45° FOV, 2352x1568px.
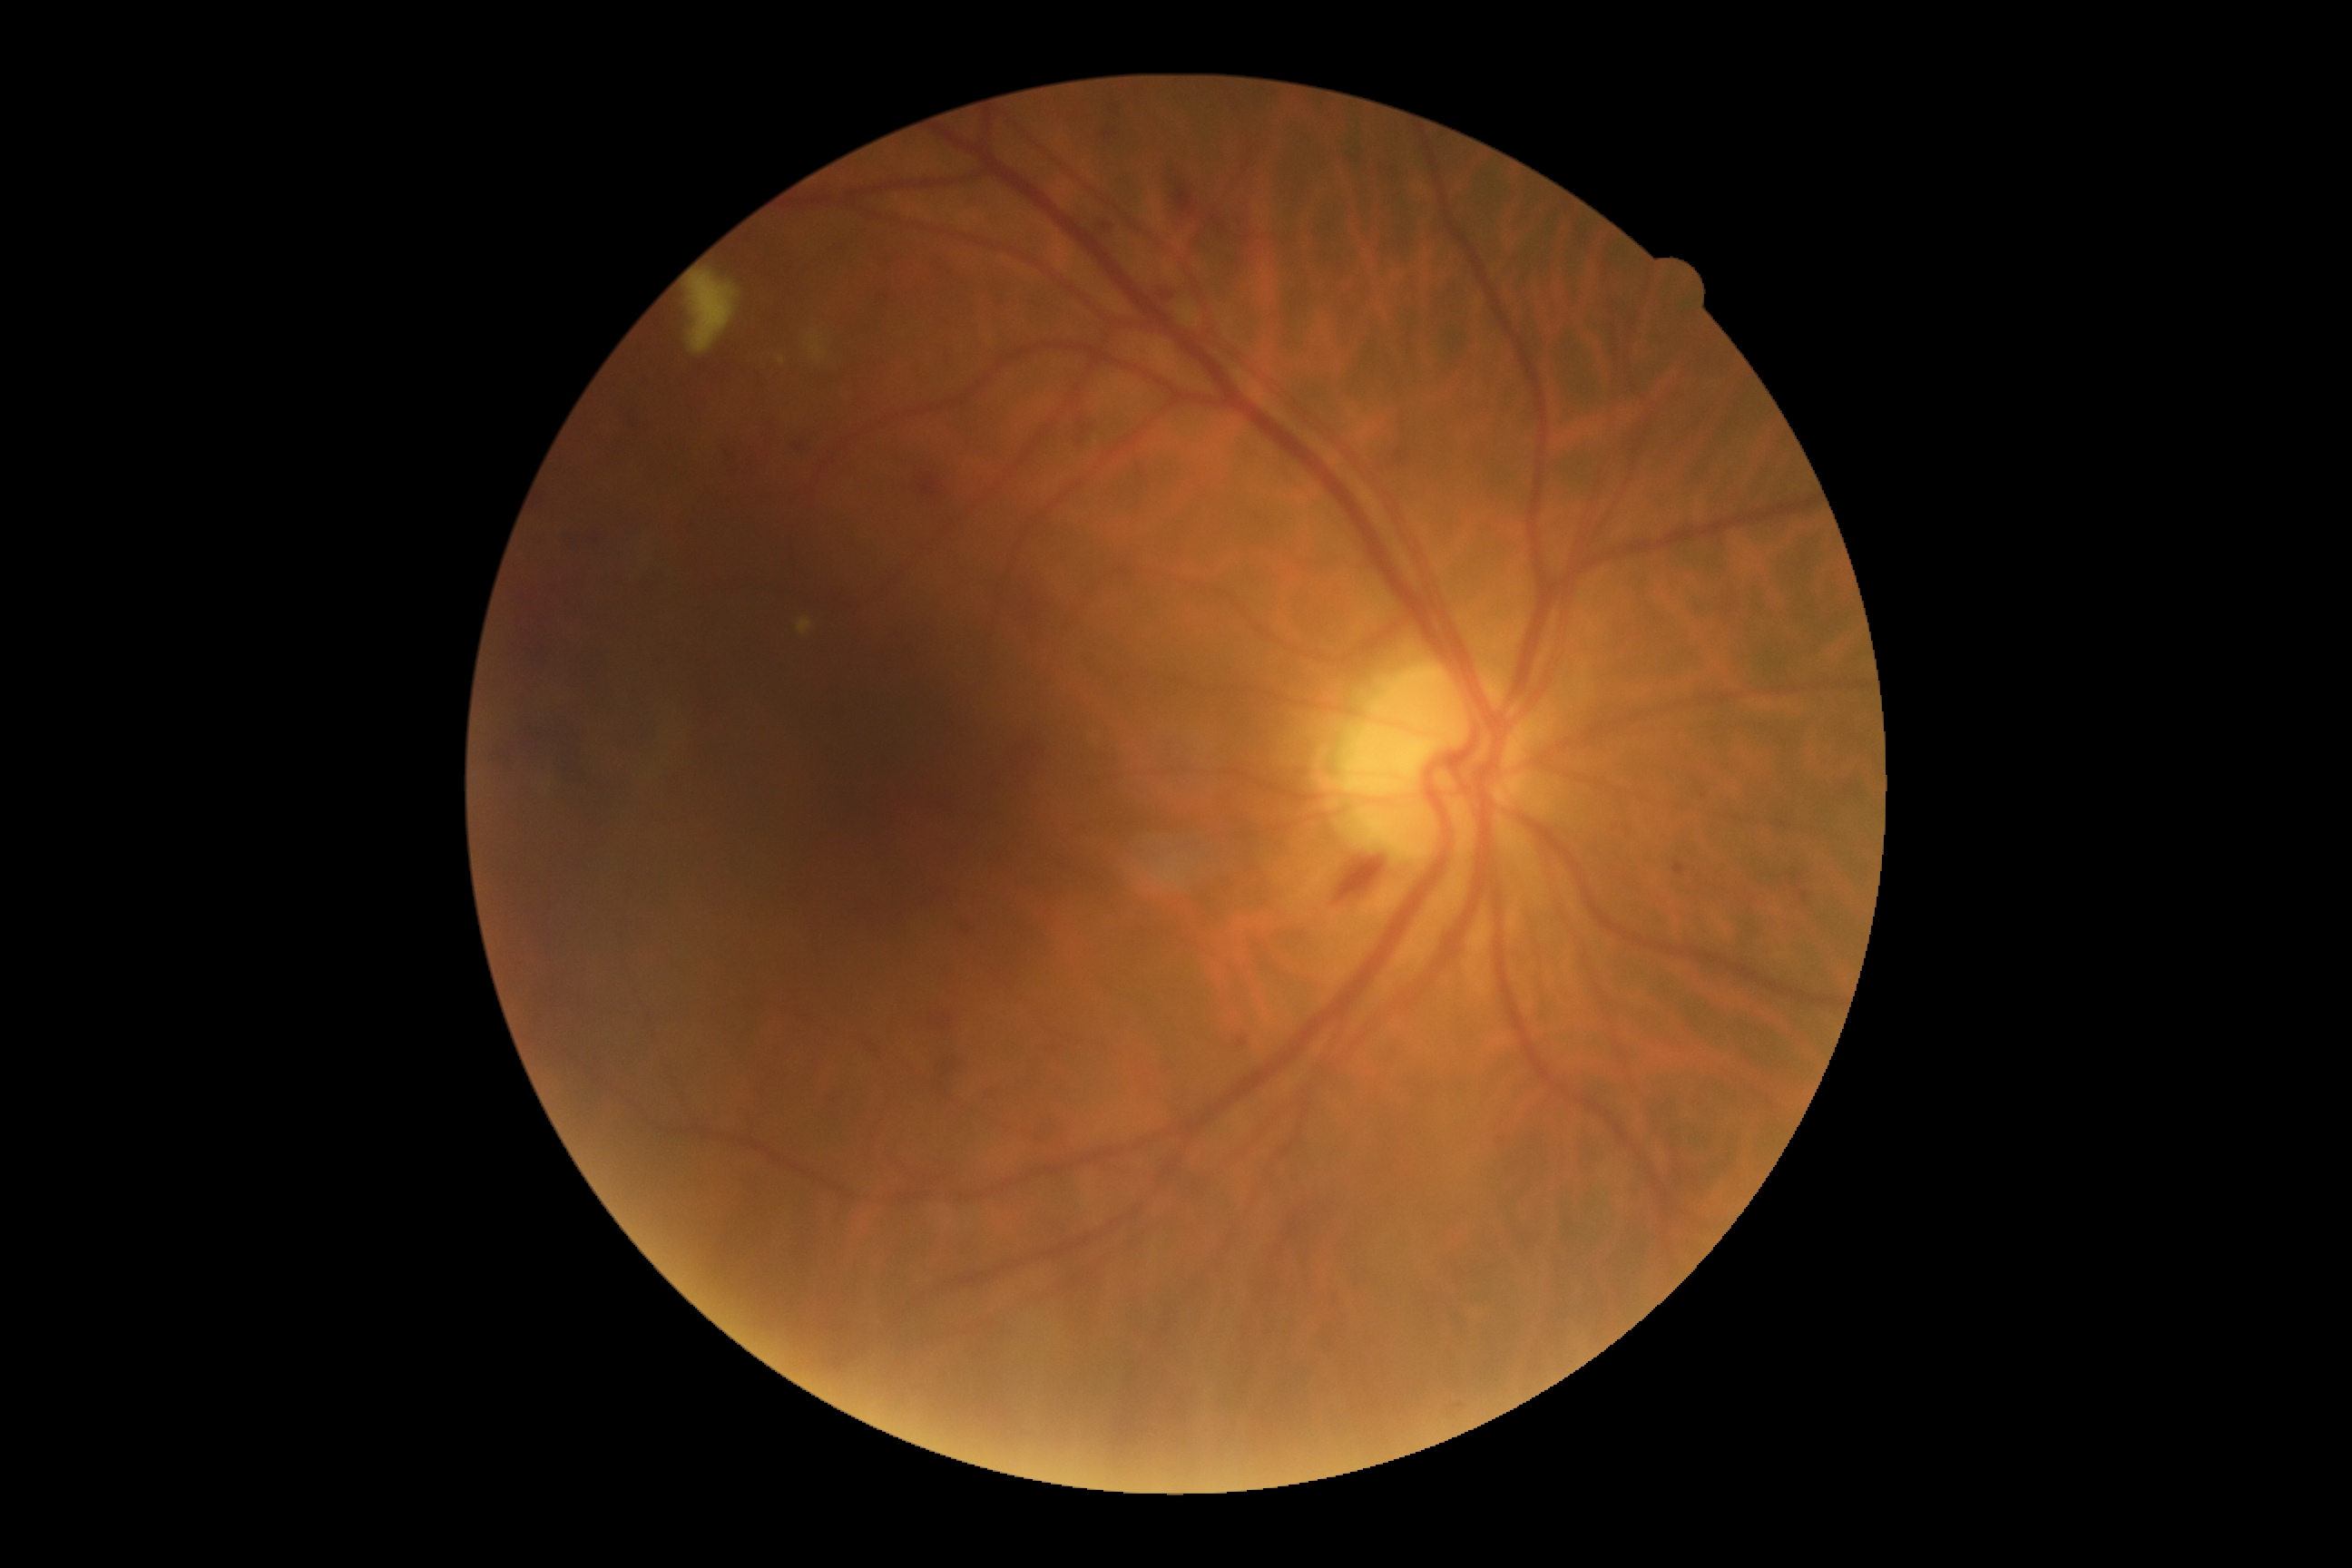 Findings:
– diabetic retinopathy (DR) — grade 2 (moderate NPDR)